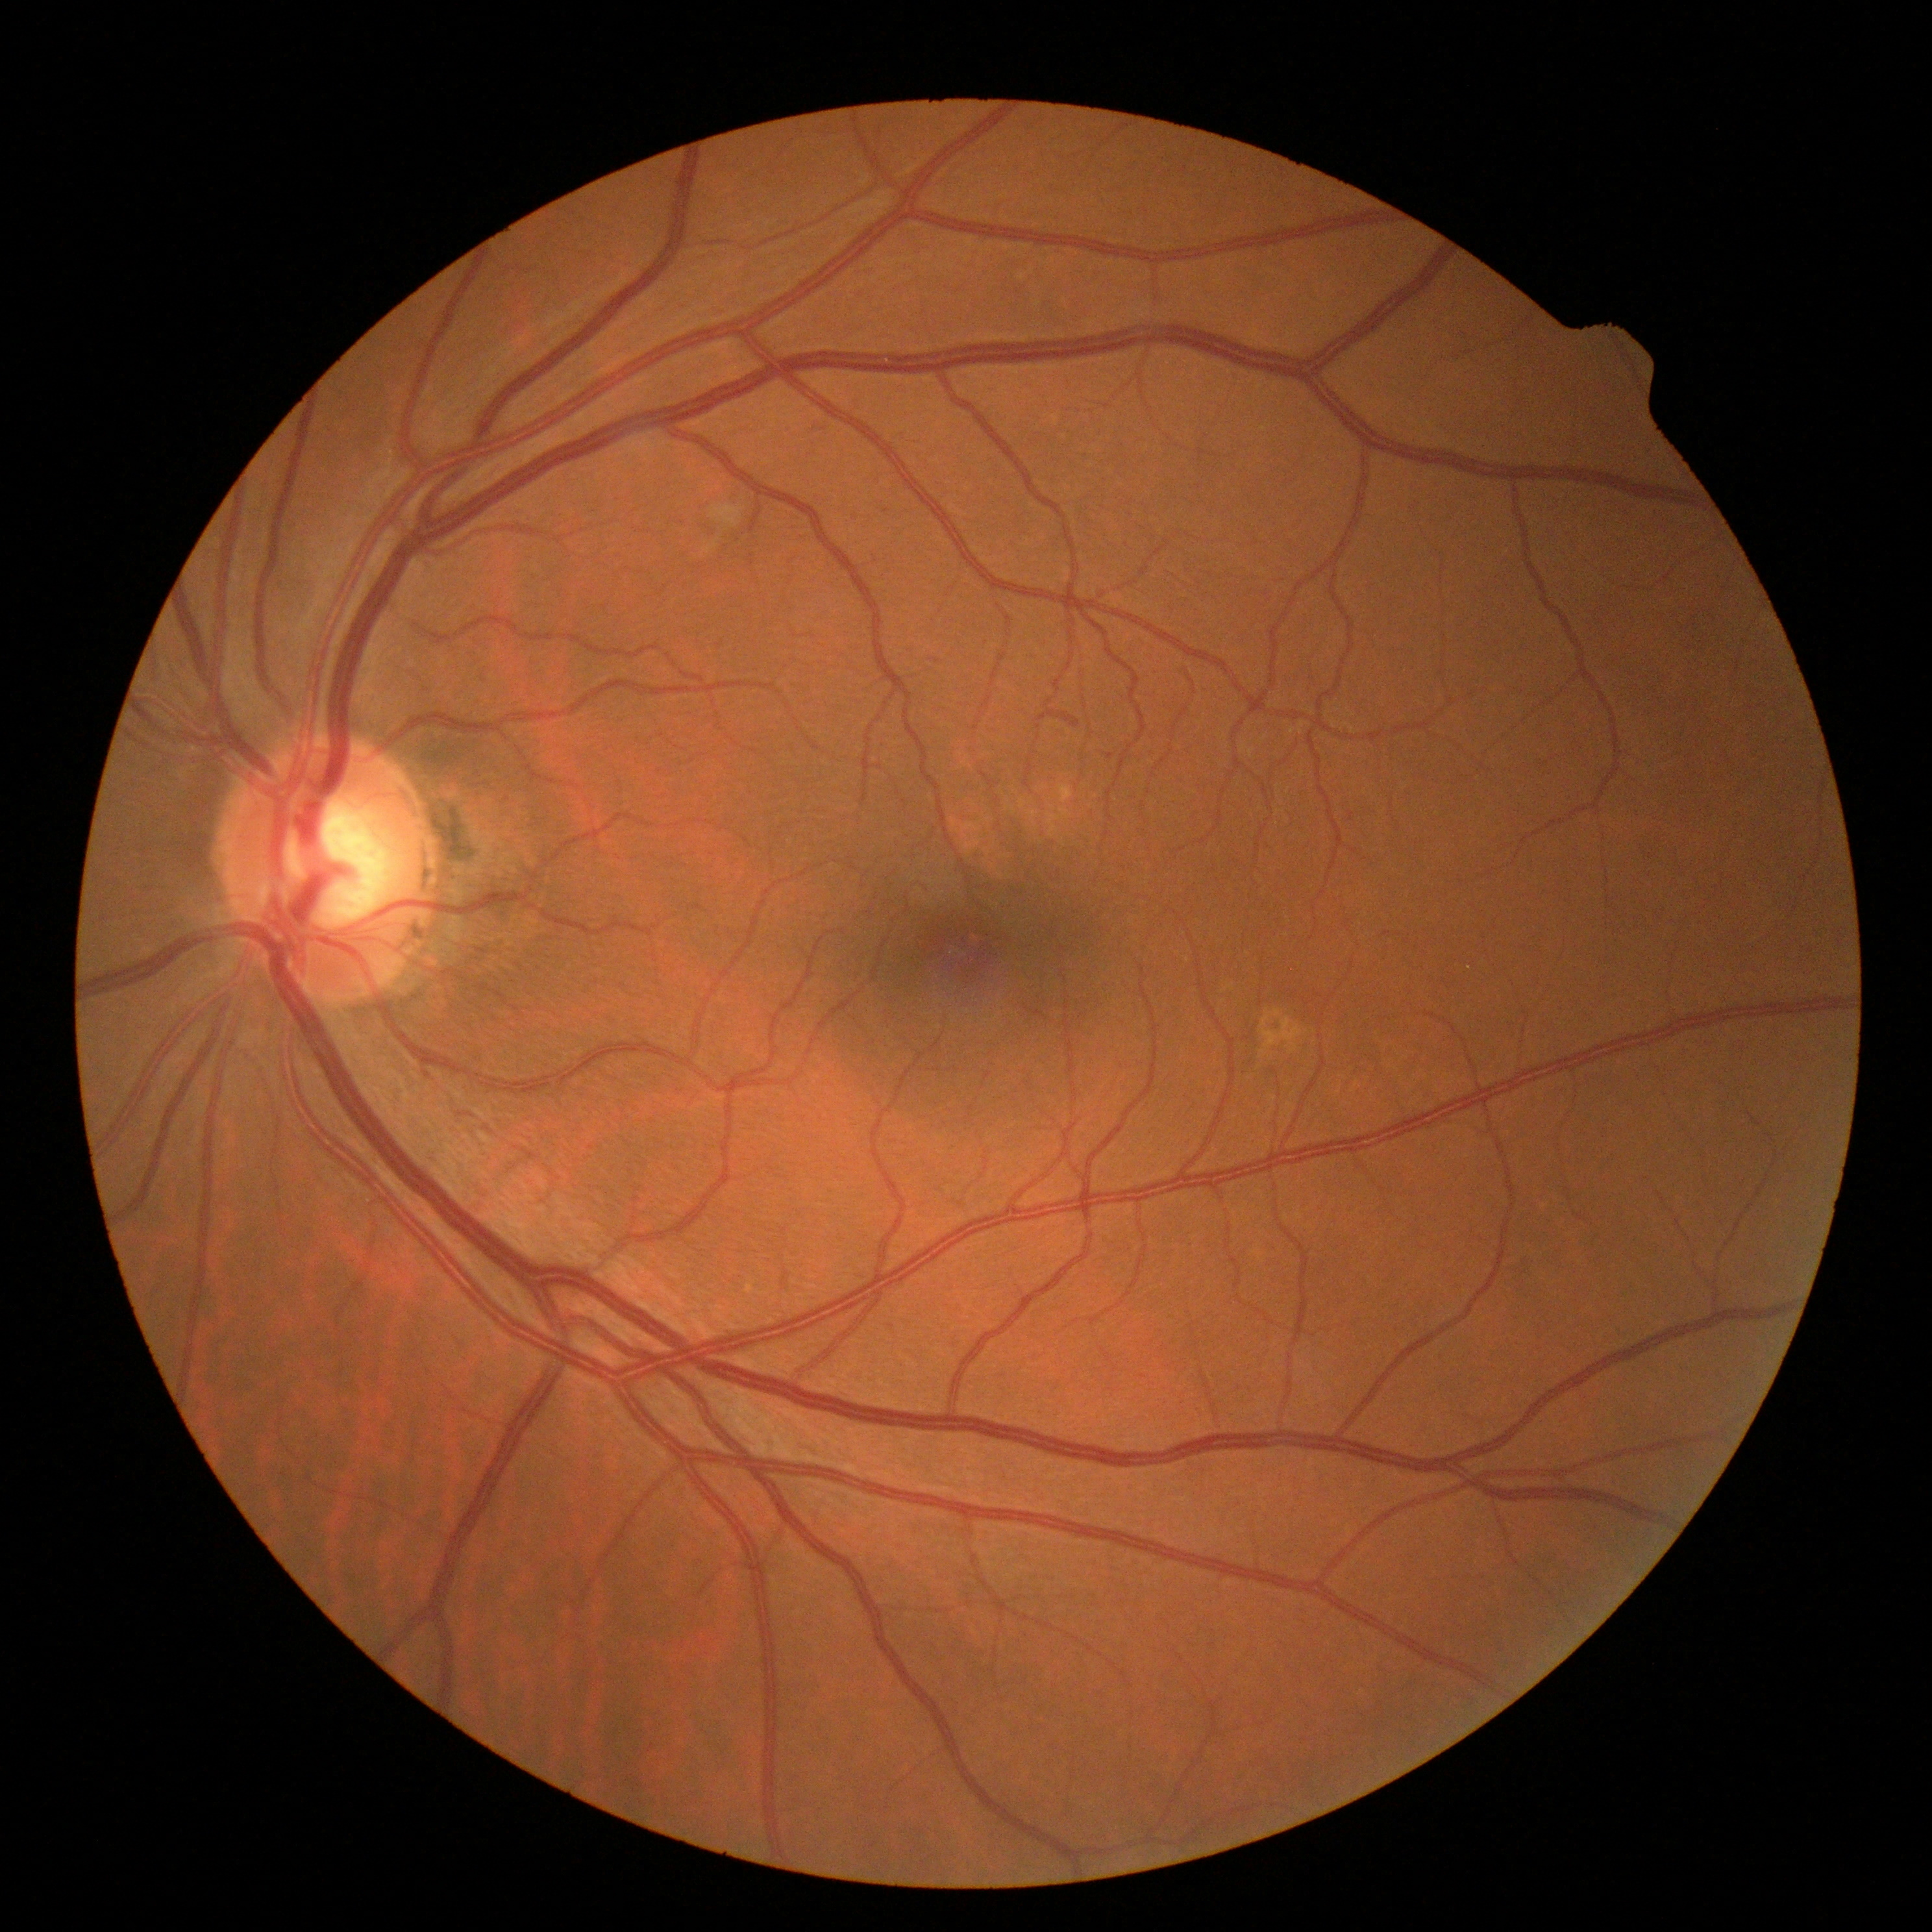 {
  "dr_grade": "grade 2",
  "dr_category": "non-proliferative diabetic retinopathy"
}